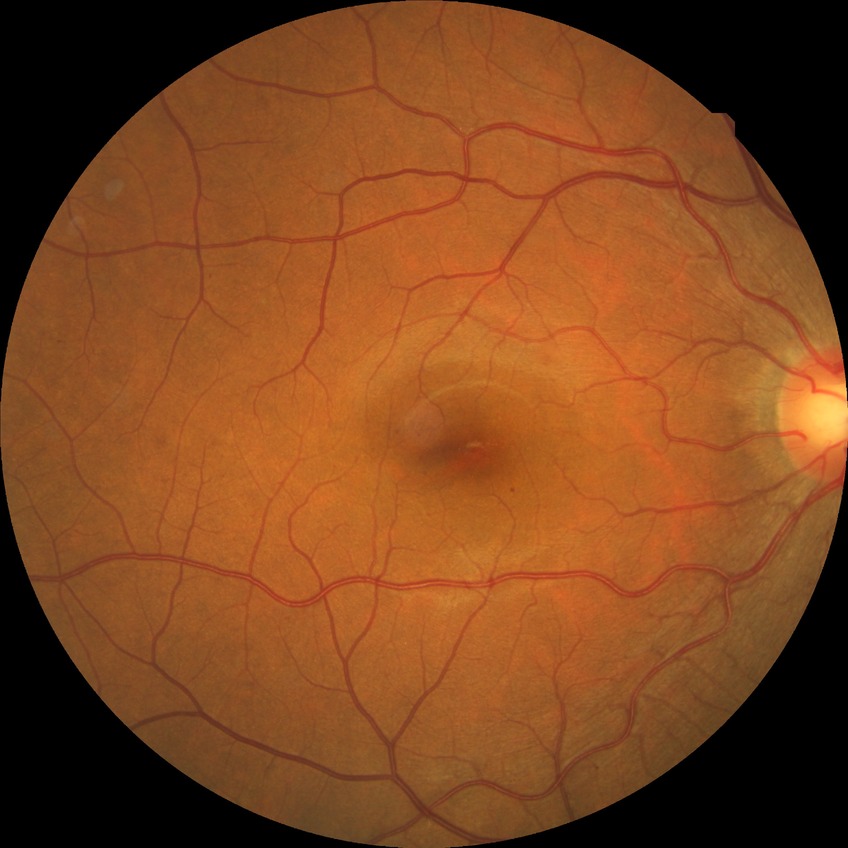

Annotations:
* retinopathy grade — simple diabetic retinopathy